Camera: NIDEK AFC-230. Nonmydriatic. DR severity per modified Davis staging.
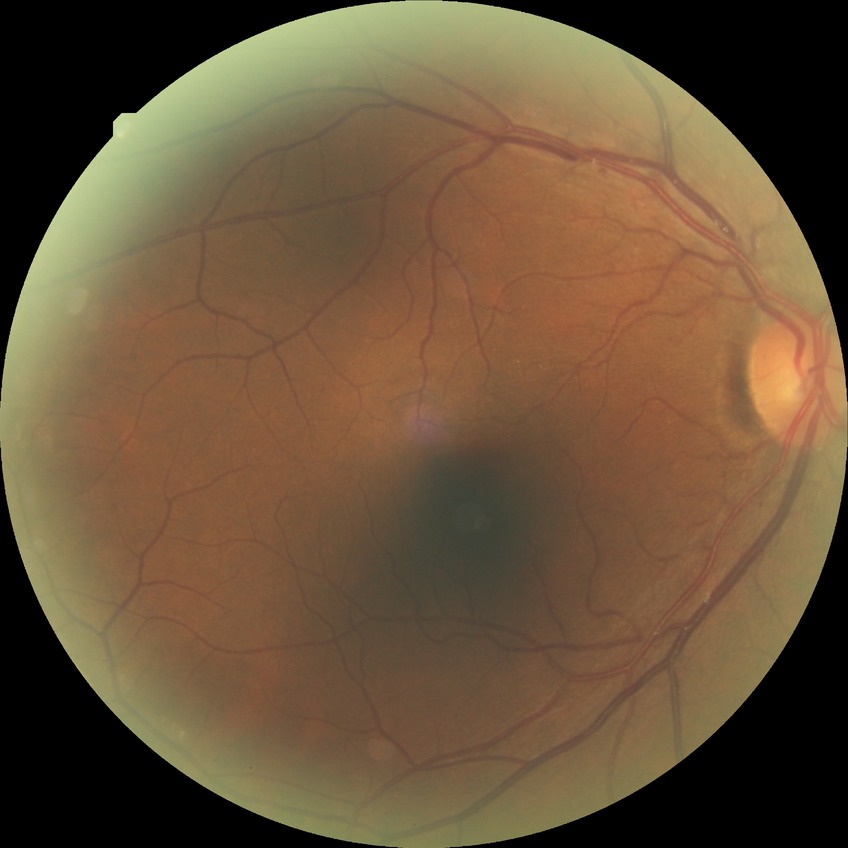 * diabetic retinopathy (DR) — NDR (no diabetic retinopathy)